Infant wide-field fundus photograph — 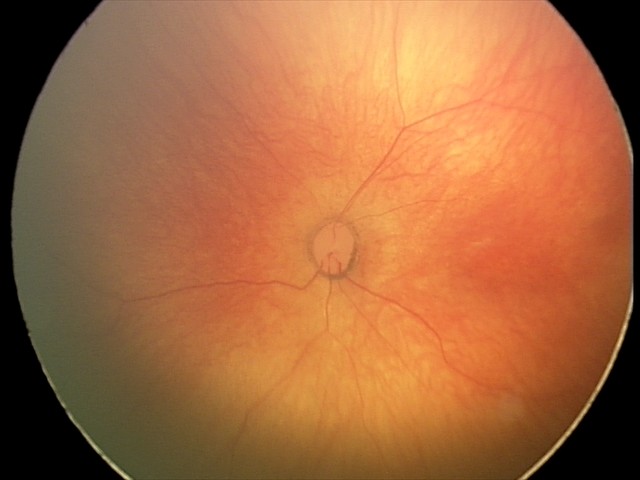 Screening: normal retinal appearance.